Fundus photo · image size 1932x1932
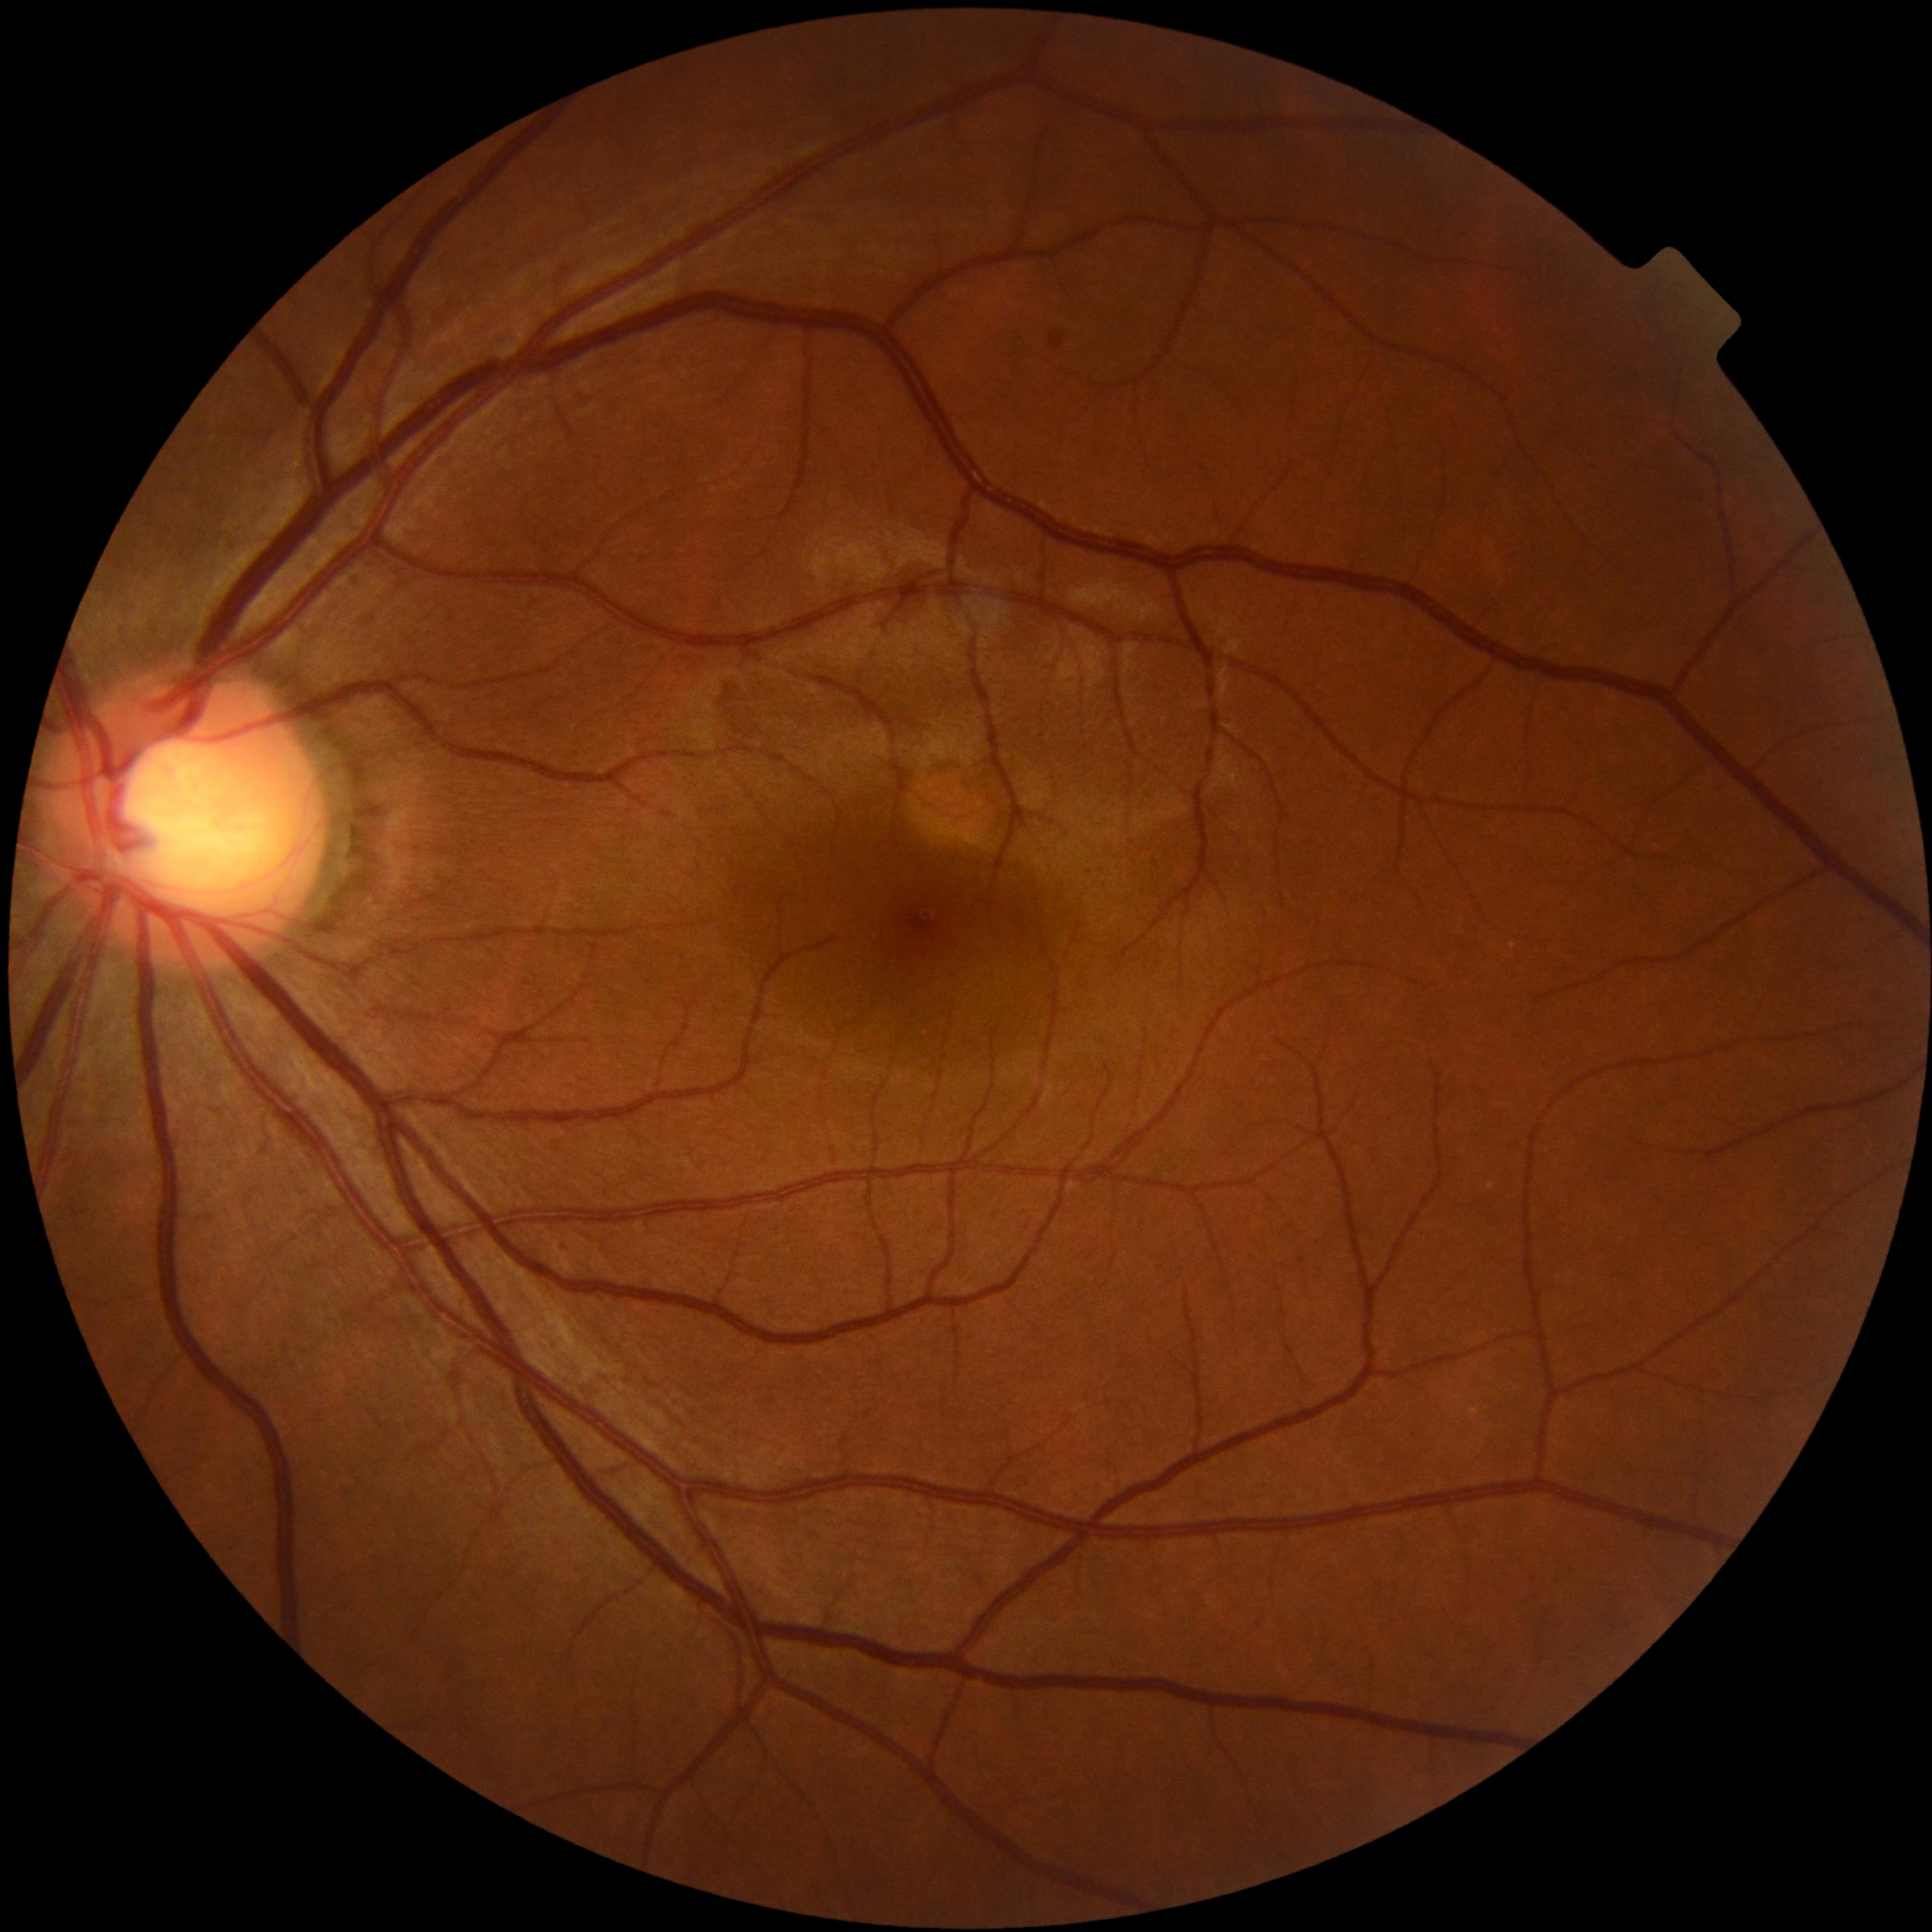 Retinopathy grade: 0 (no apparent retinopathy). No diabetic retinal disease findings.